Acquired on the Phoenix ICON. Wide-field fundus photograph of an infant — 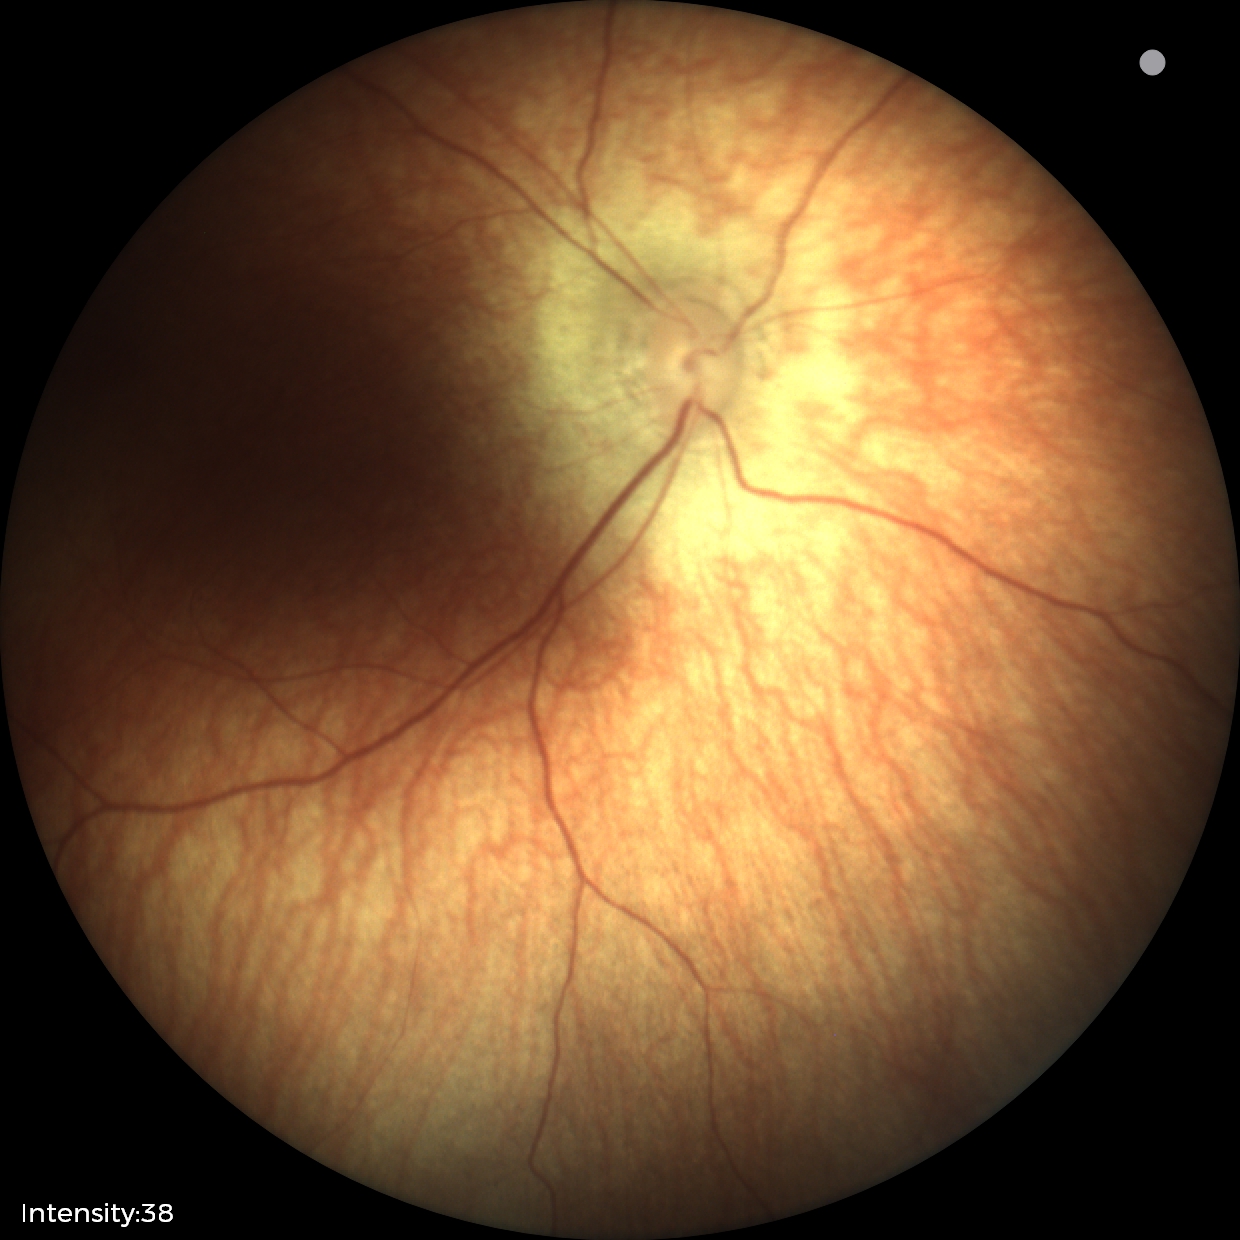 Assessment: physiological